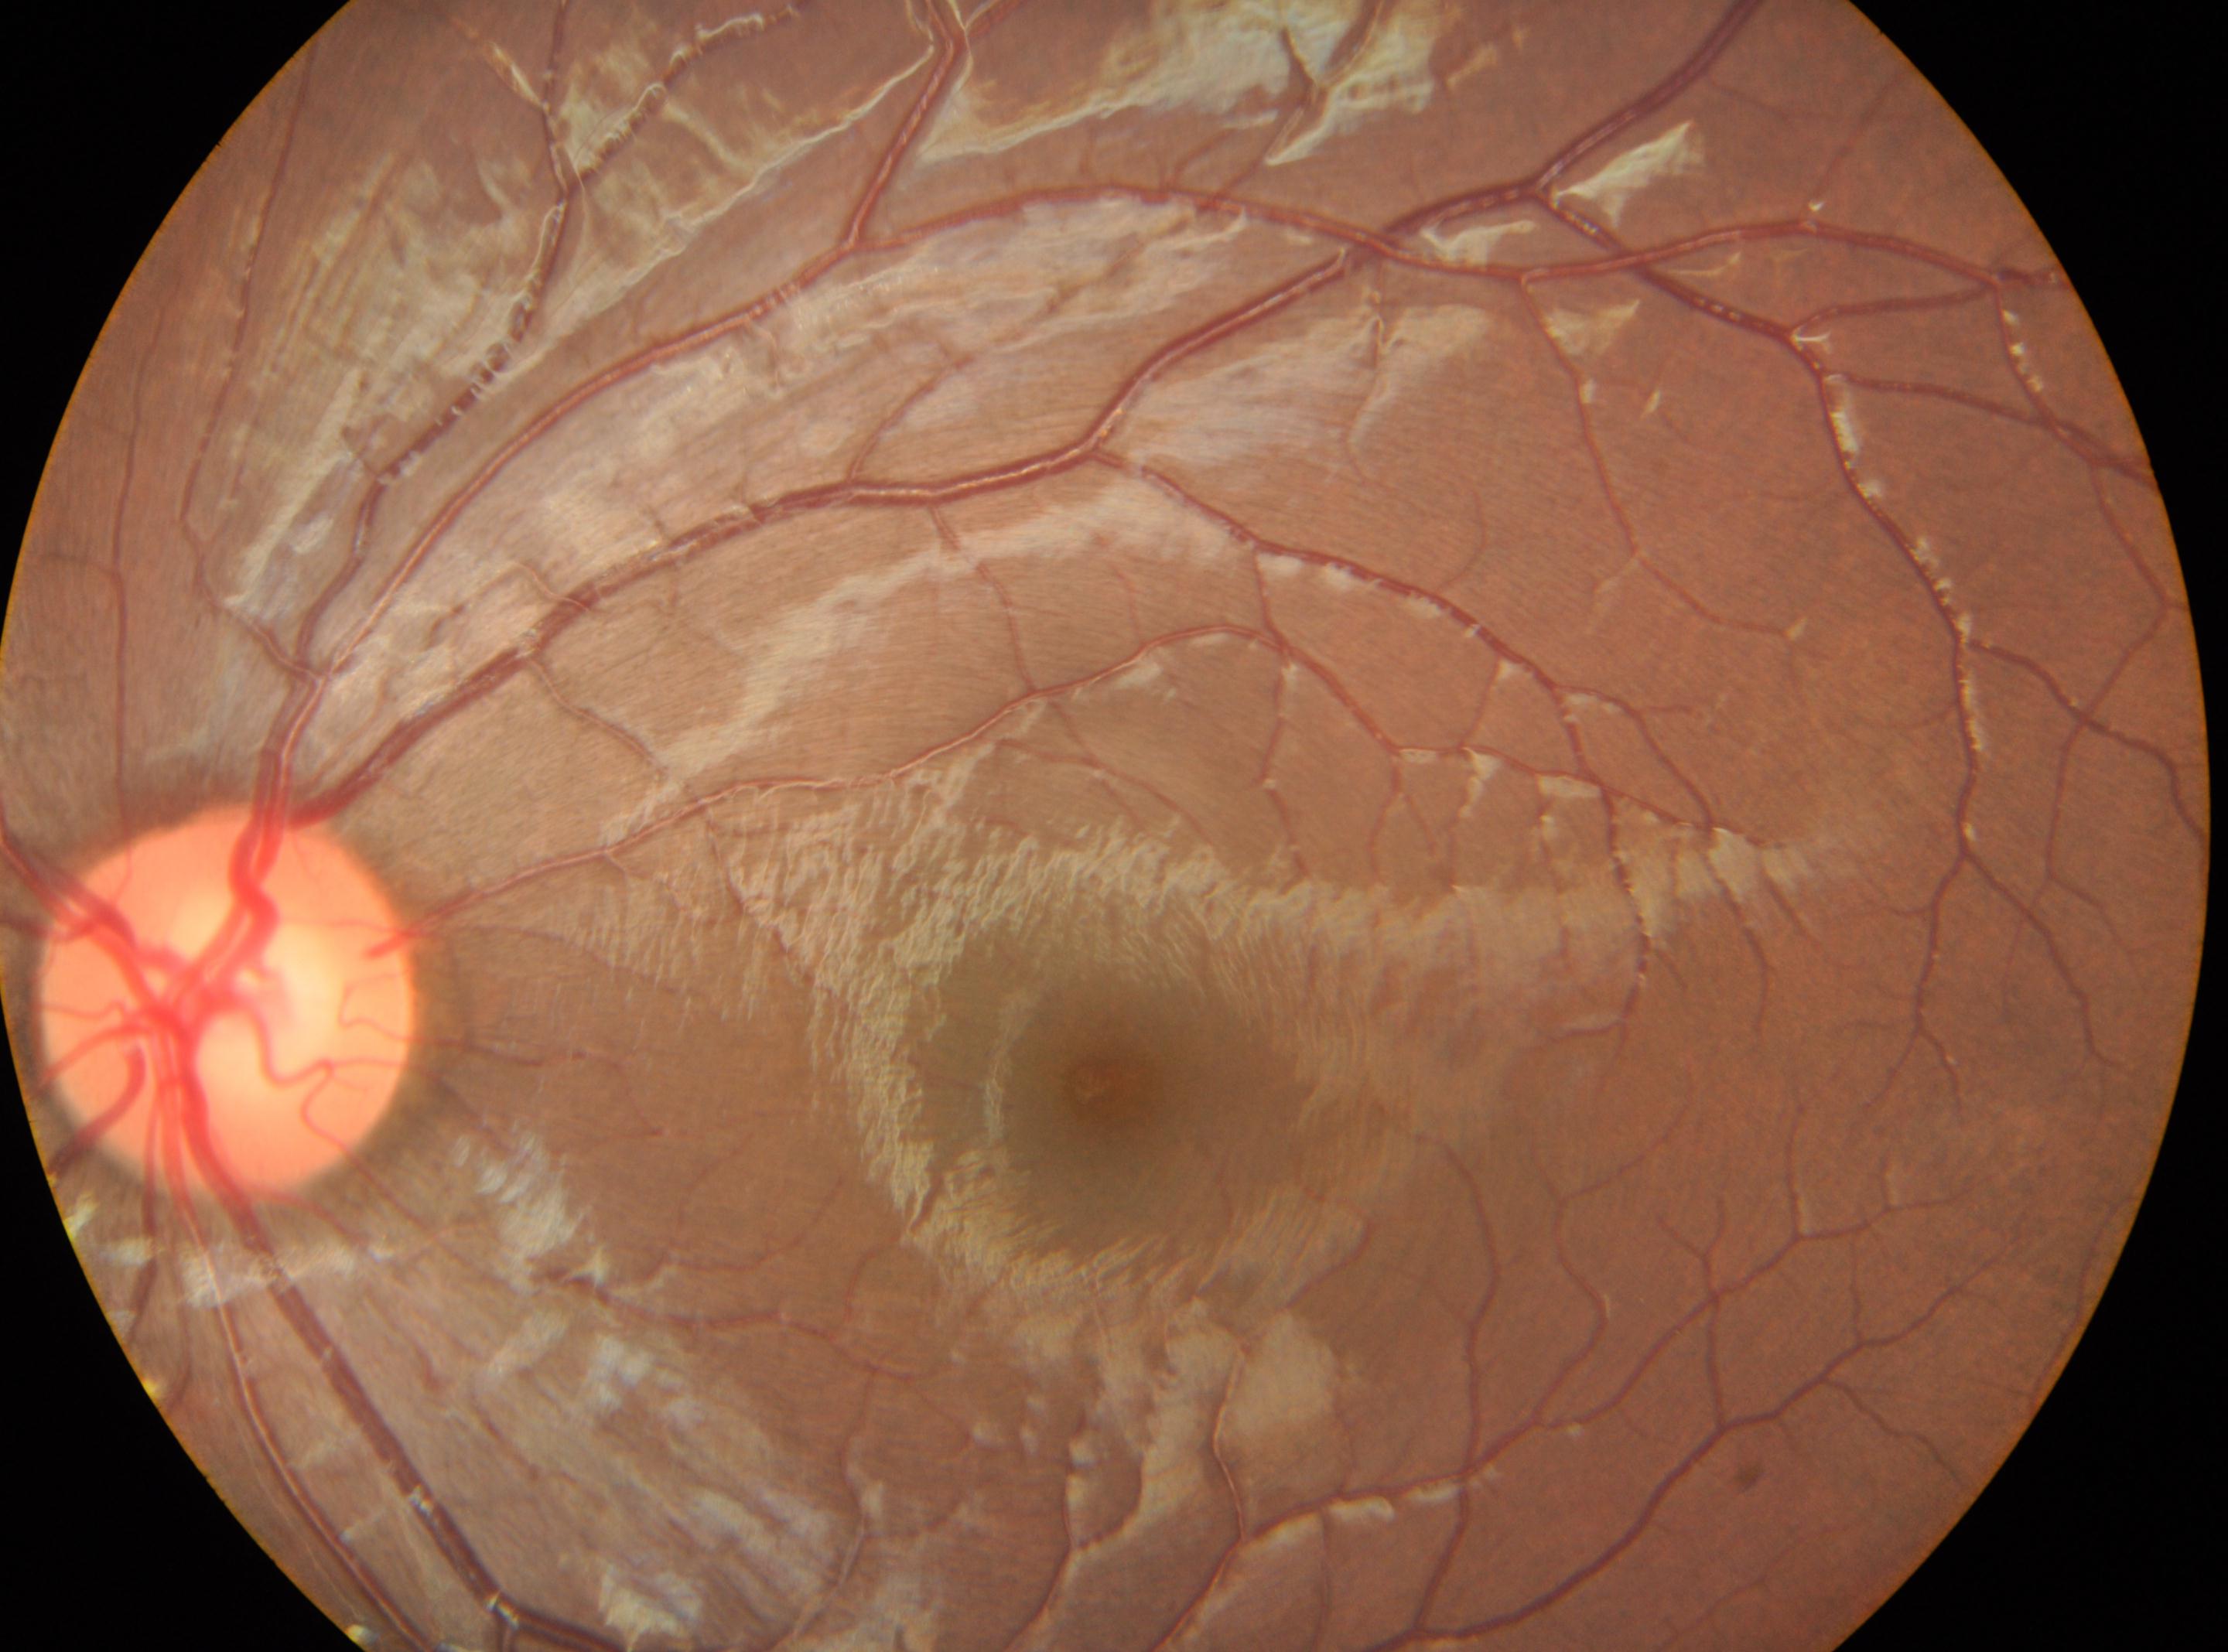 • DR impression: No apparent diabetic retinopathy
• retinopathy grade: 0
• fovea: (1111,1084)
• laterality: left
• optic disc: (227,1007)